Disc-centered field · Nidek AFC-330 · image size 240x240.
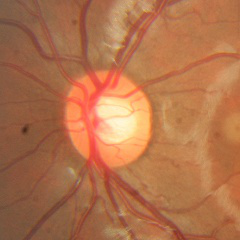

Glaucoma stage = no evidence of glaucoma.